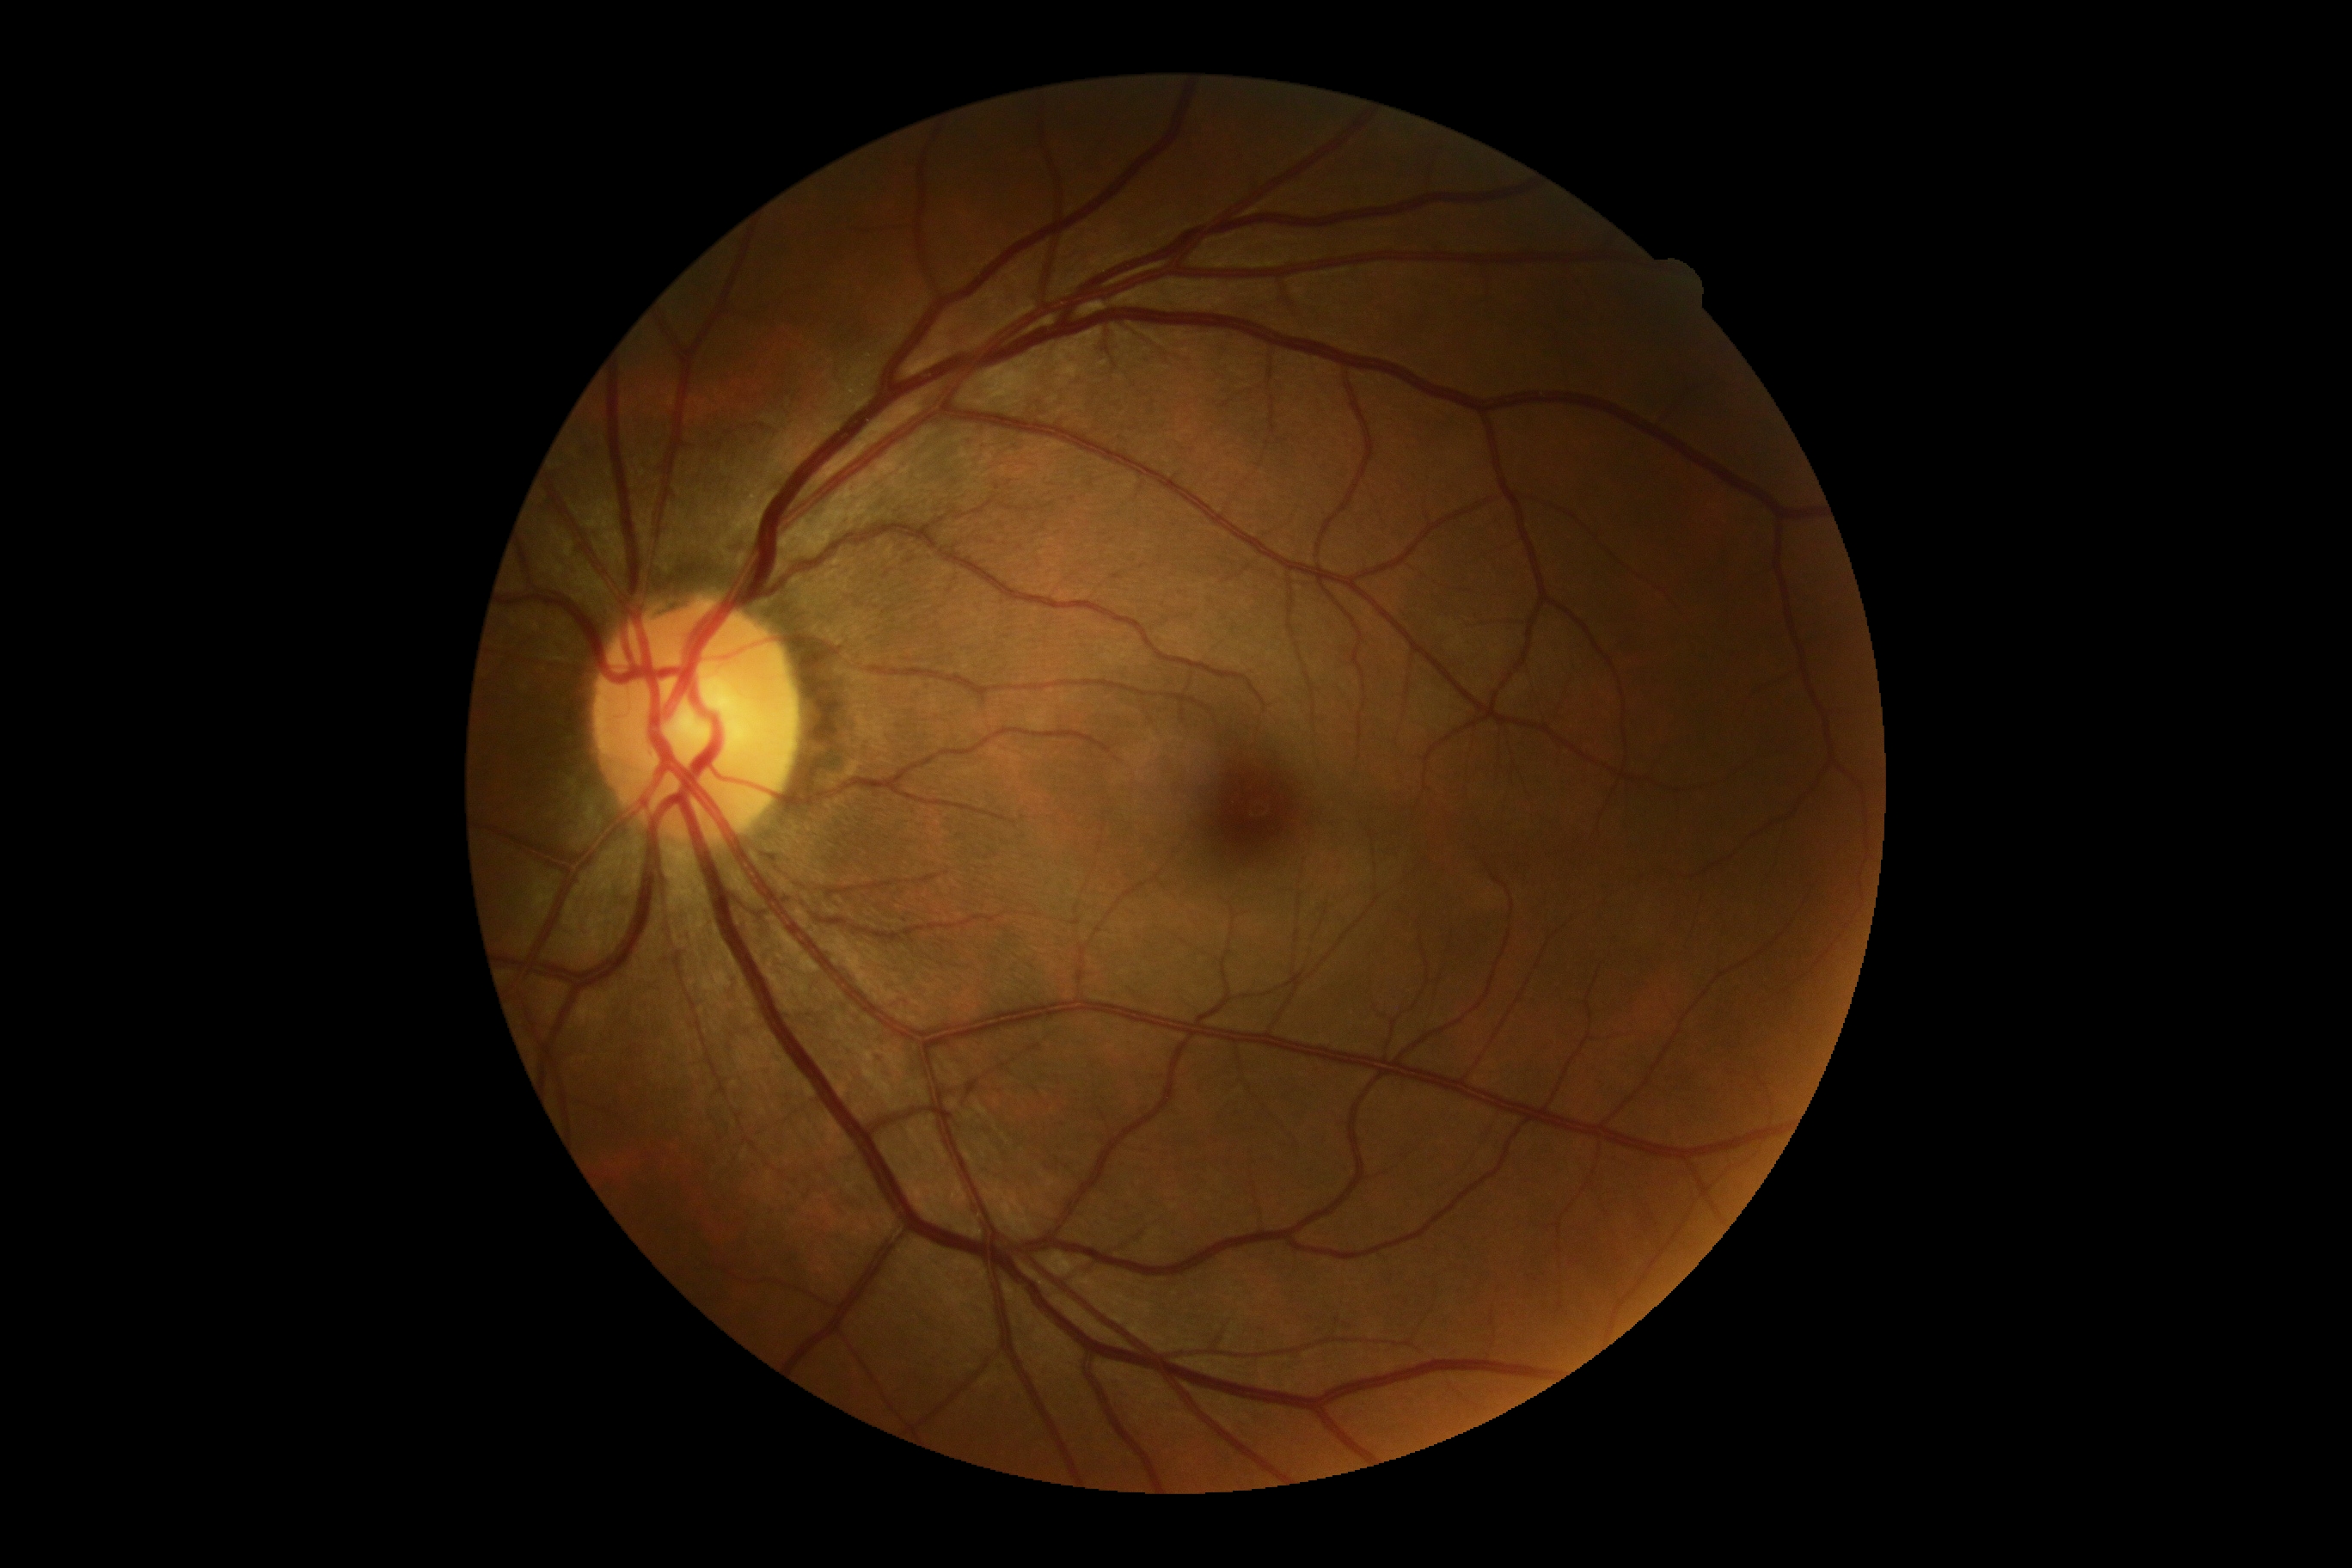 {
  "dr_grade": "grade 0 (no apparent retinopathy)",
  "dr_impression": "no apparent DR"
}